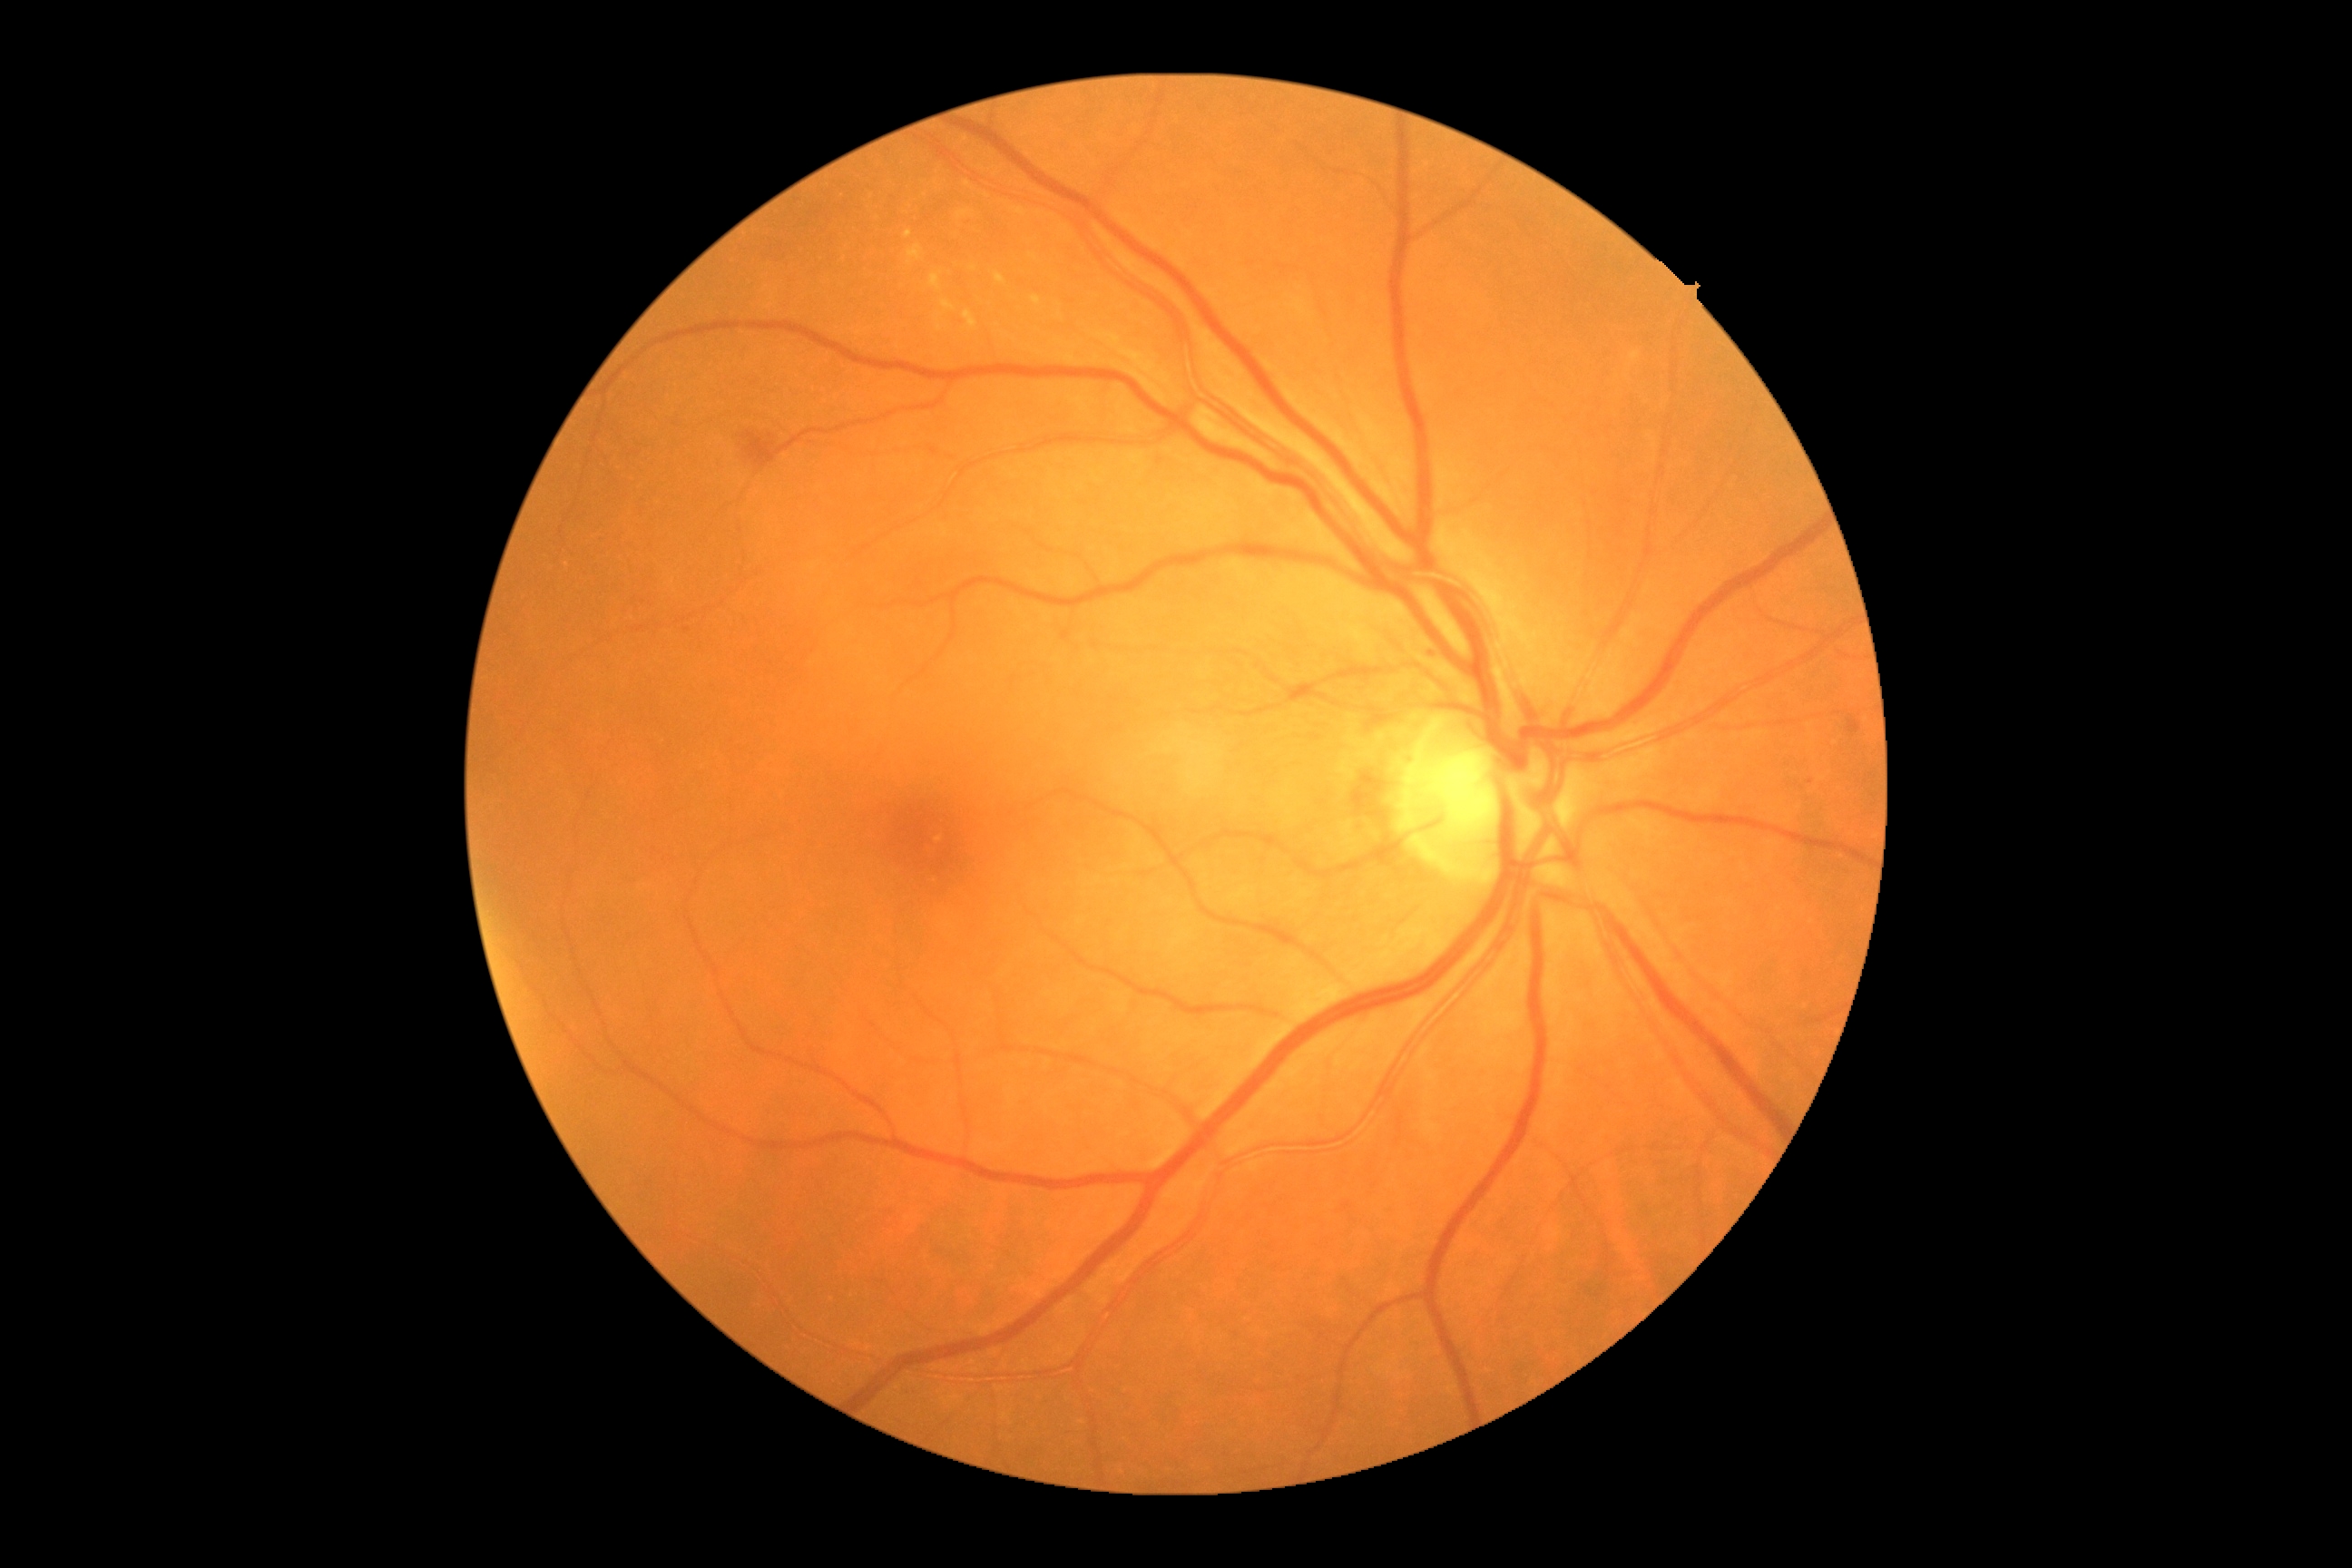
partial: true
dr_grade: 2
lesions:
  ex:
    - rect(963, 309, 977, 329)
    - rect(905, 231, 912, 239)
    - rect(908, 244, 923, 266)
    - rect(930, 273, 941, 291)
    - rect(995, 273, 1006, 286)
    - rect(1032, 297, 1041, 308)
    - rect(1631, 351, 1642, 362)
    - rect(941, 300, 956, 311)
  ex_small_centers:
    - (1015; 340)
    - (1033; 256)
    - (973; 268)
    - (567; 565)
    - (940; 329)
  he:
    - rect(743, 433, 778, 469)
  ma:
    - rect(1427, 649, 1438, 663)
  ma_small_centers:
    - (688; 630)
  se: []